Color fundus photograph
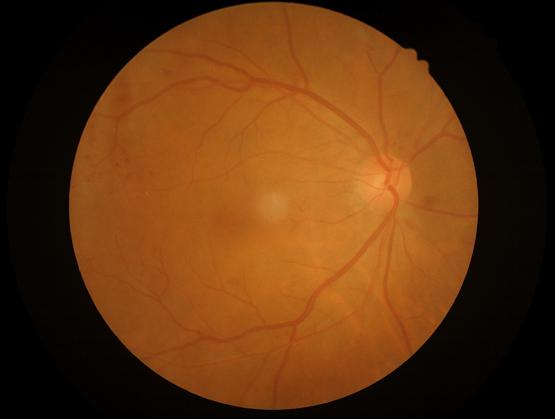
No over- or under-exposure. The image is clear. Good dynamic range.